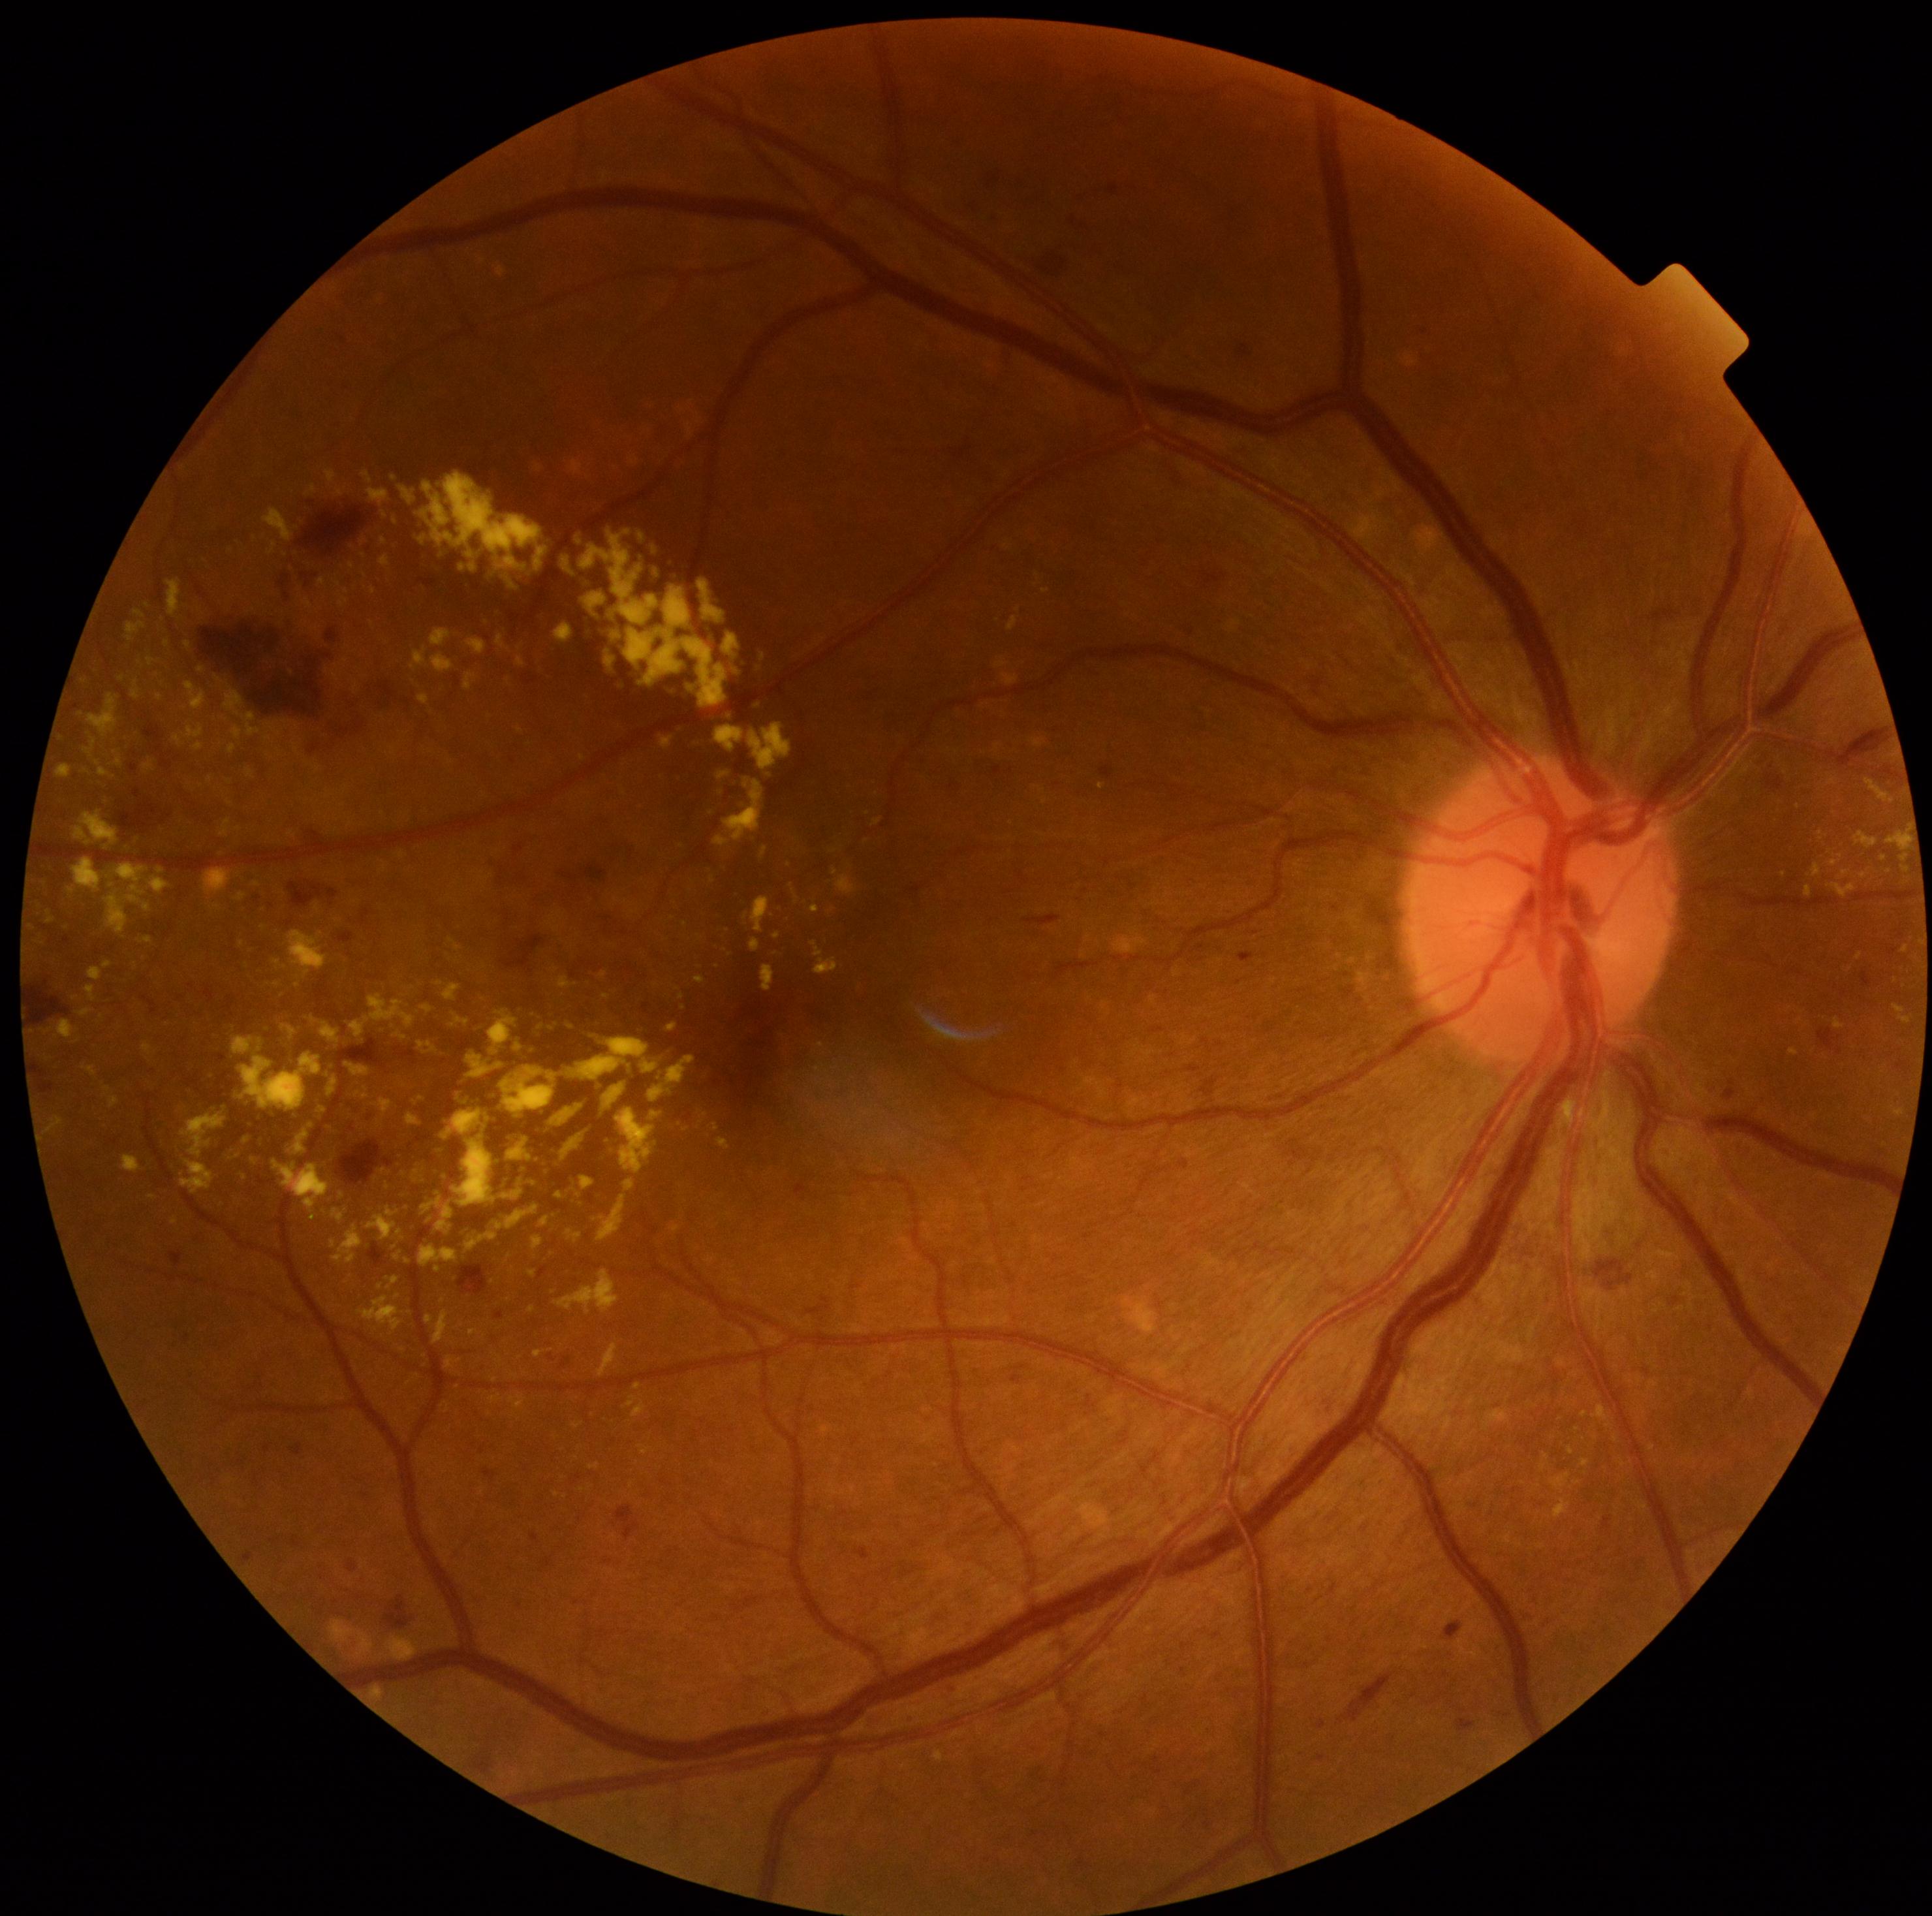
Retinopathy is moderate non-proliferative diabetic retinopathy (grade 2)
Representative lesions:
hard exudates (partial) = rect(142, 1043, 155, 1055); rect(1551, 1473, 1572, 1492); rect(750, 723, 792, 772); rect(330, 1239, 337, 1248); rect(332, 672, 341, 682); rect(173, 723, 204, 747); rect(750, 1342, 755, 1351); rect(750, 939, 760, 952); rect(399, 486, 416, 505); rect(381, 538, 387, 546); rect(246, 768, 255, 779); rect(557, 977, 572, 990); rect(634, 1383, 642, 1390)
Small hard exudates approximately at 222, 745; 1837, 863; 668, 1297; 462, 569; 582, 758; 384, 869